NIDEK AFC-230 fundus camera, modified Davis grading, 45° field of view, 848 by 848 pixels, no pharmacologic dilation — 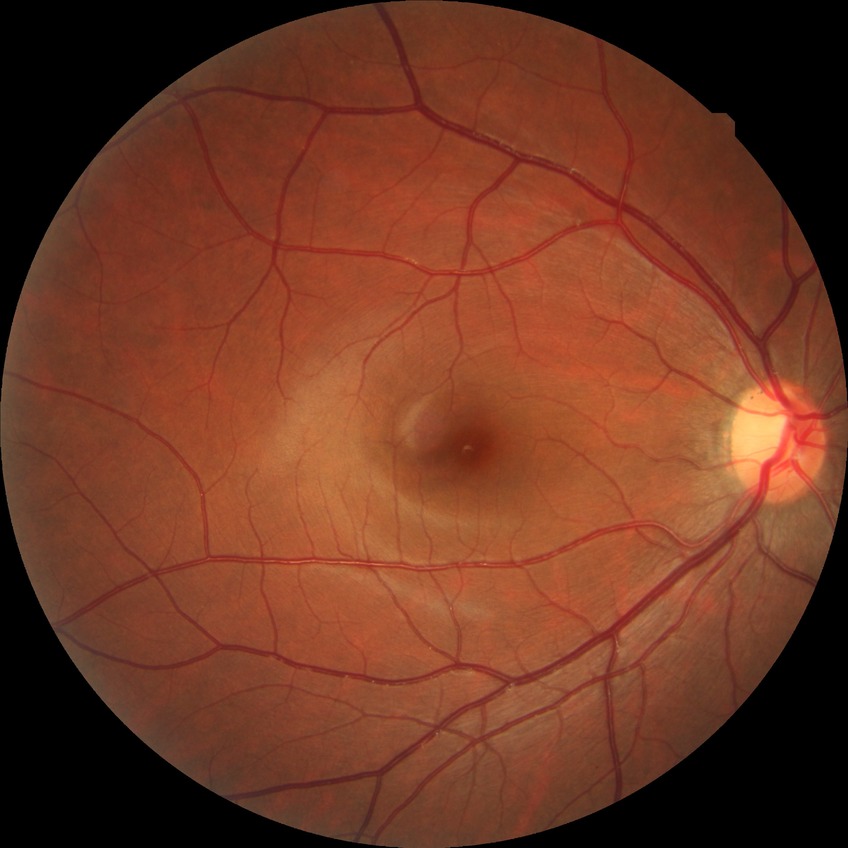
diabetic retinopathy (DR) = NDR (no diabetic retinopathy).